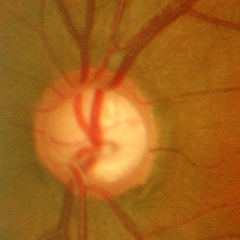
Q: What is the glaucoma diagnosis?
A: Yes — advanced glaucoma.